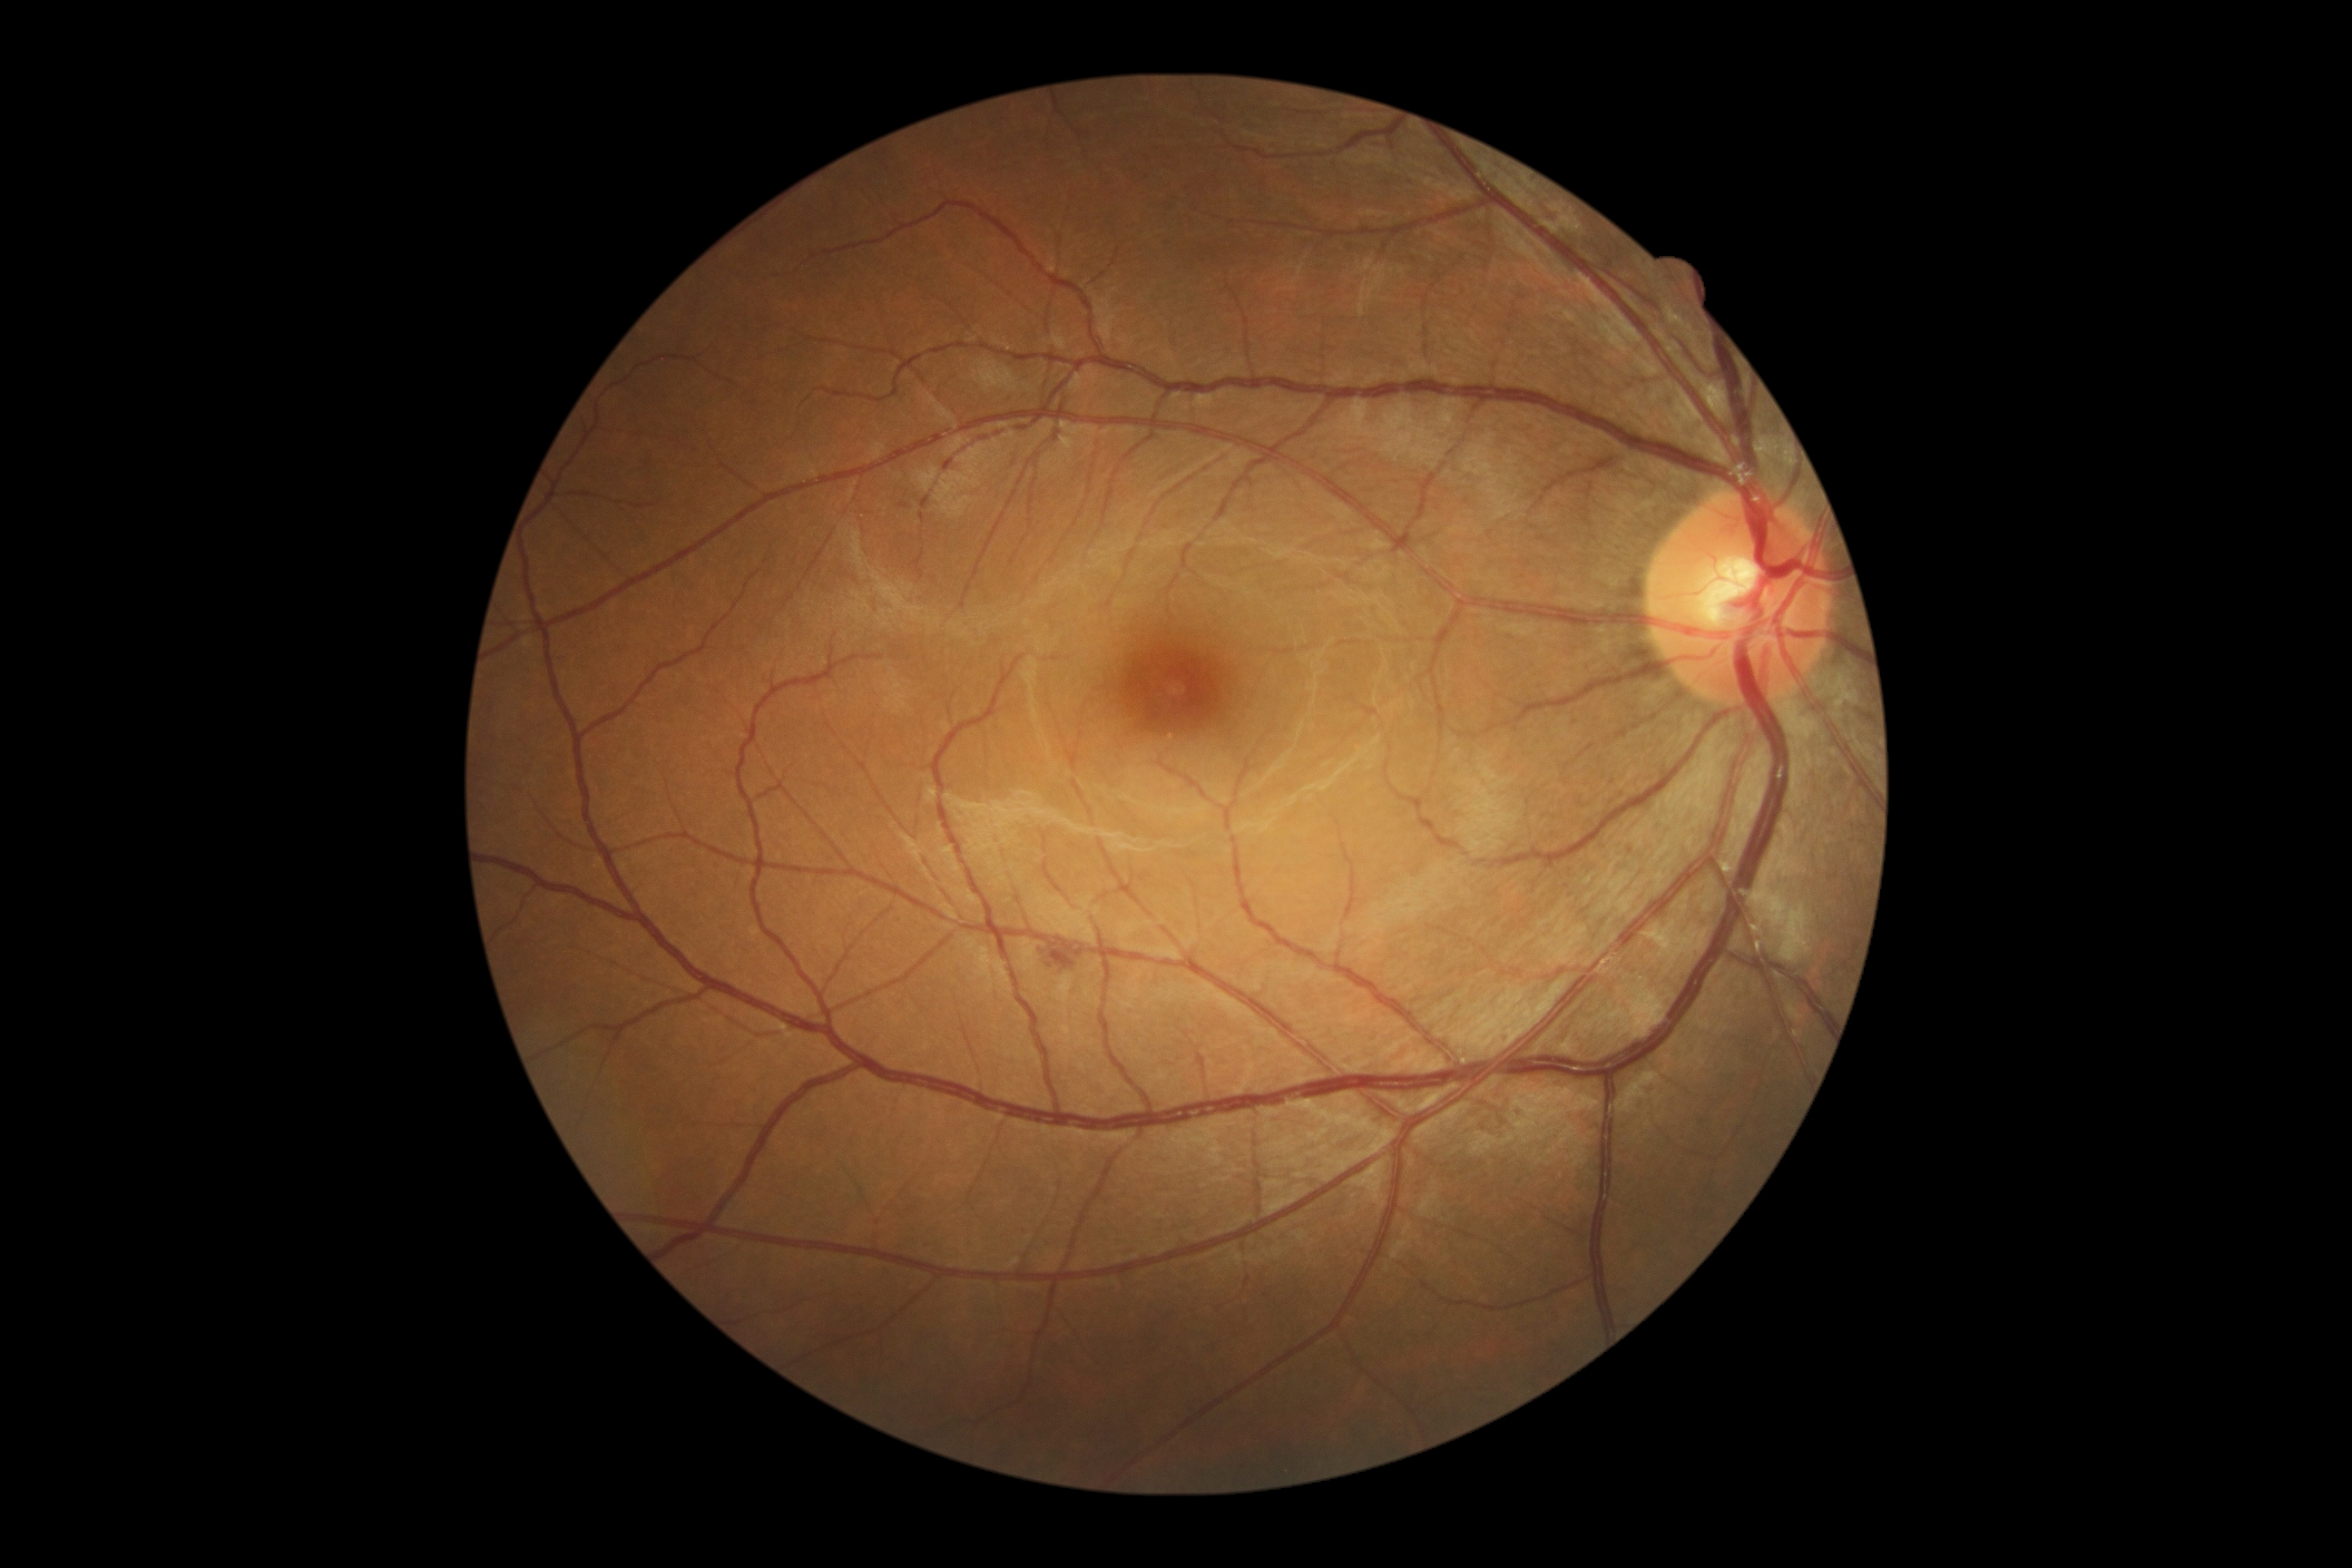

Diabetic retinopathy (DR) is 2. No hard exudates (EXs) identified. Hemorrhages (HEs) at x1=1052 y1=941 x2=1079 y2=966. No microaneurysms (MAs) identified. No soft exudates (SEs) identified.